UWF retinal mosaic.
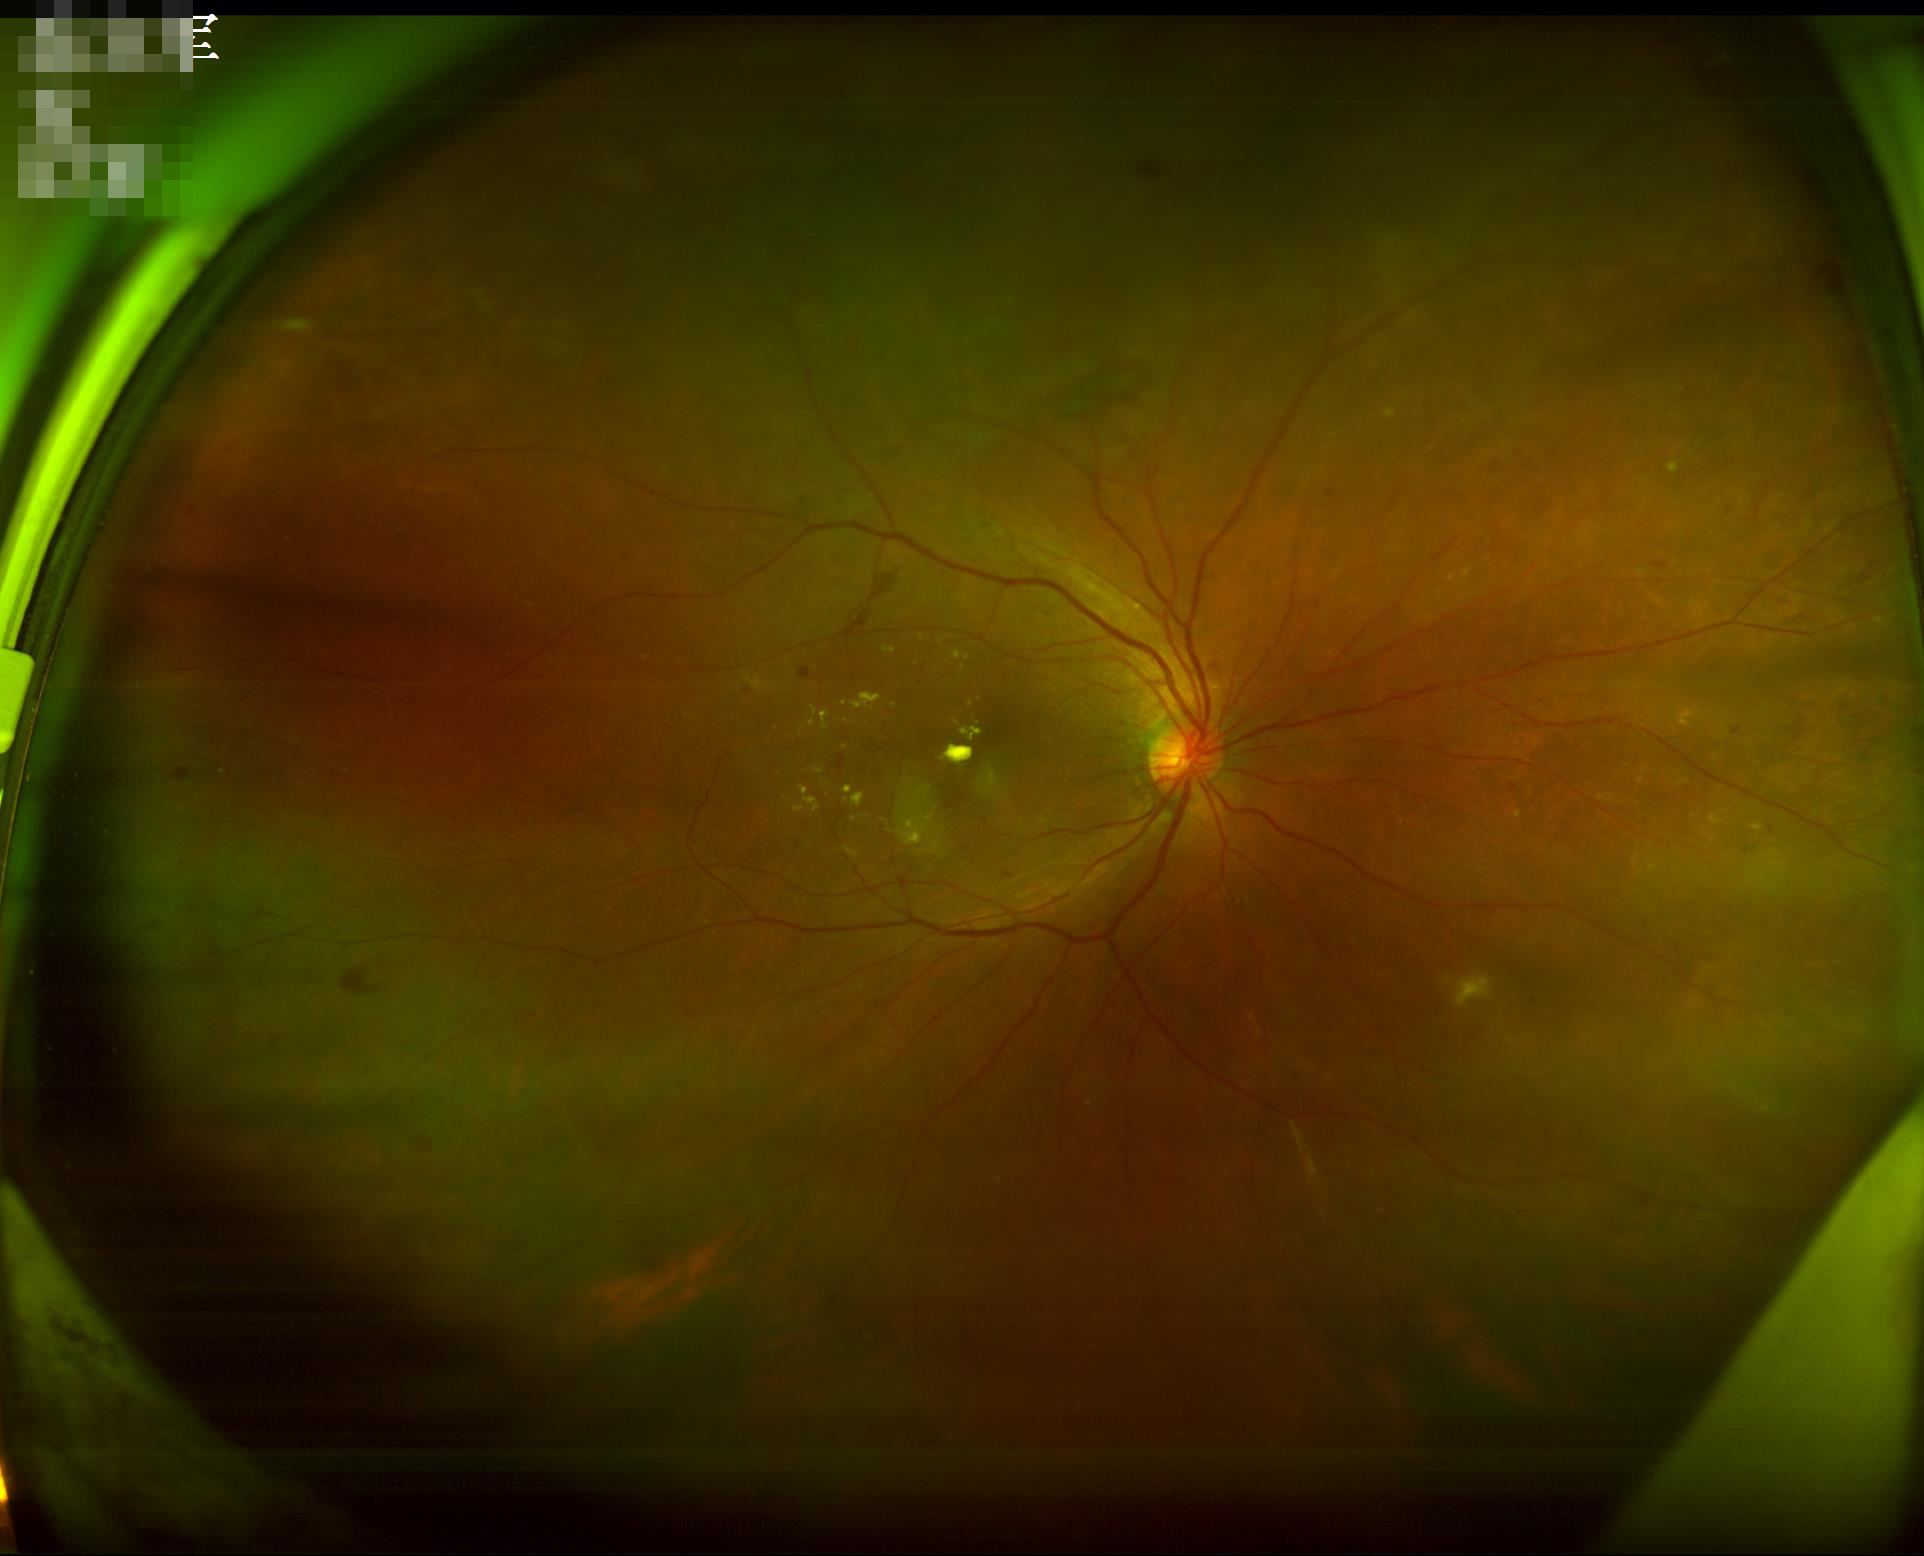
Illumination: satisfactory
Overall image quality: satisfactory
Contrast: good